Modified Davis classification:
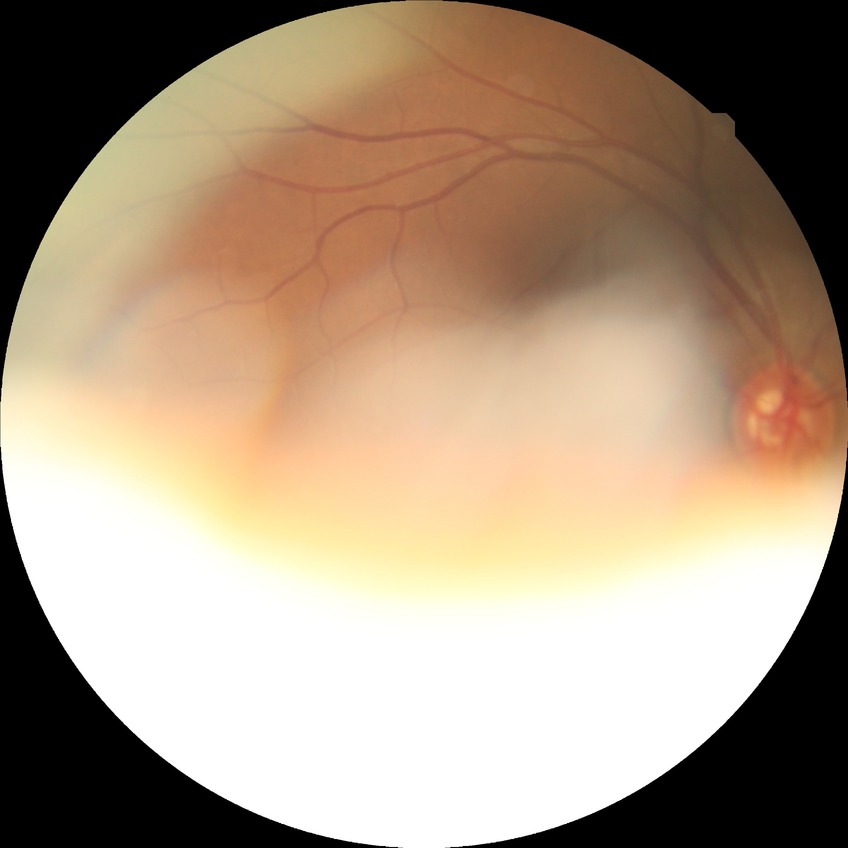
modified Davis classification = no diabetic retinopathy.